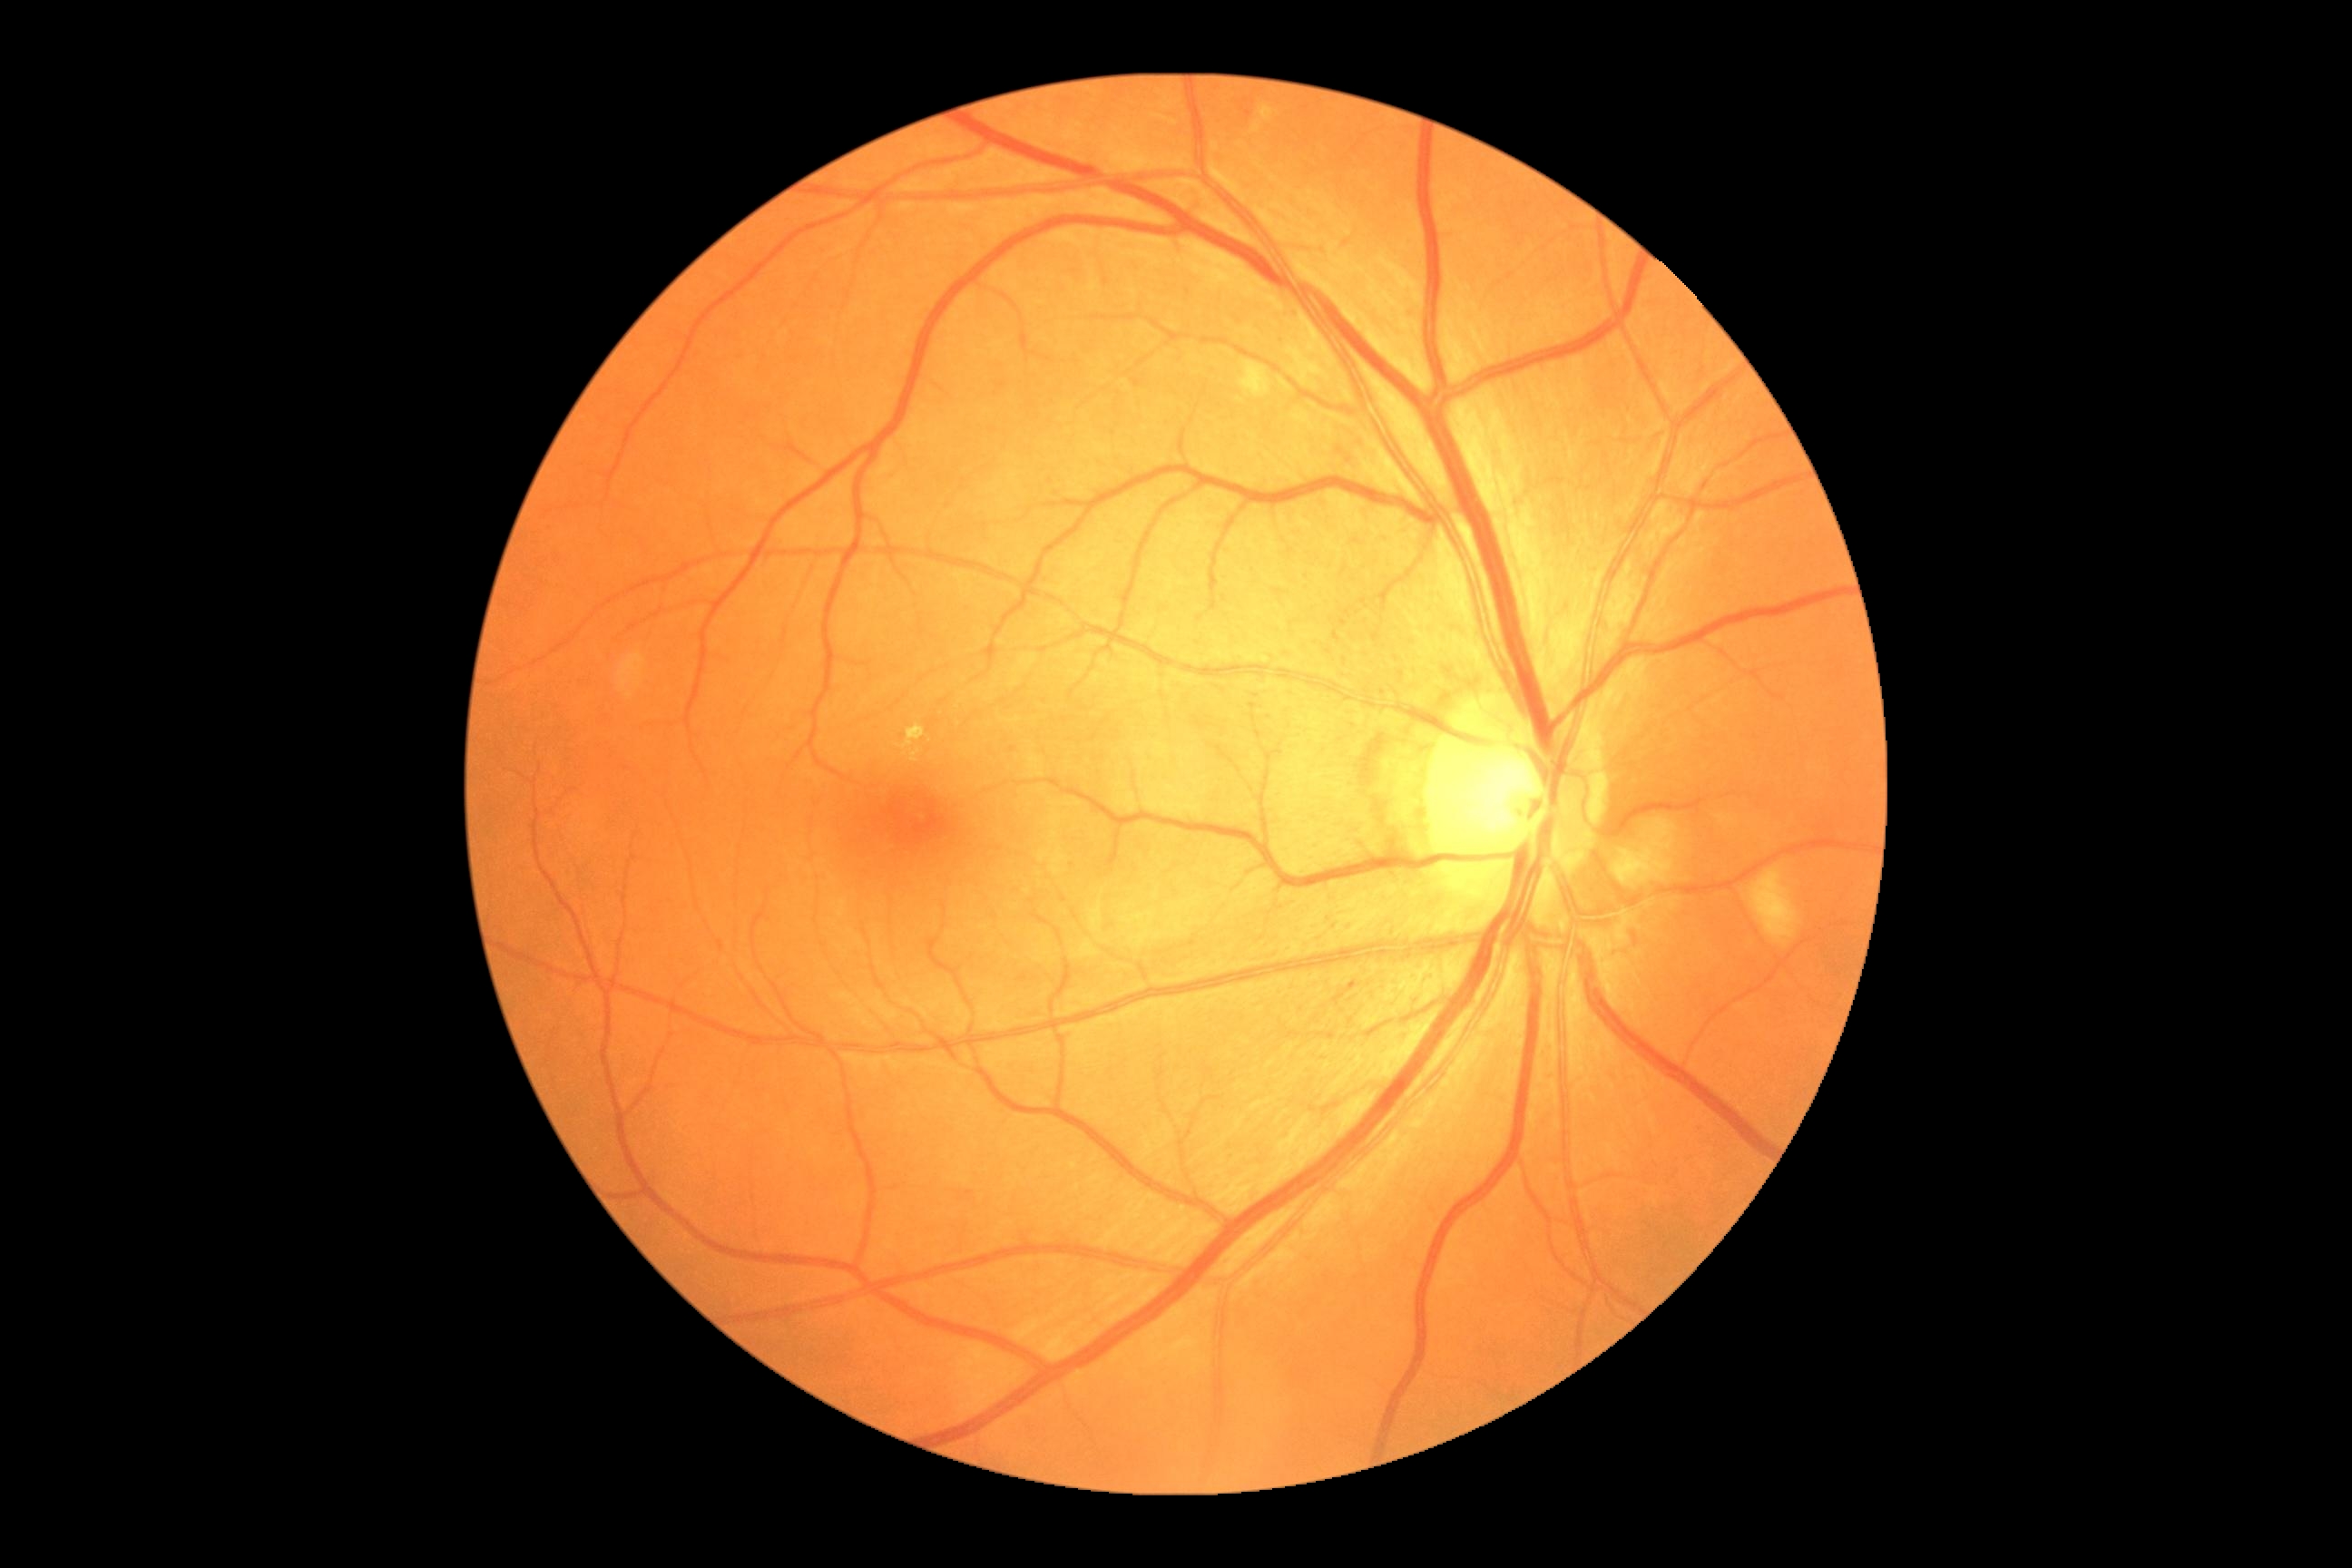 {"dr_grade": "2/4"}